Wide-field fundus image from infant ROP screening
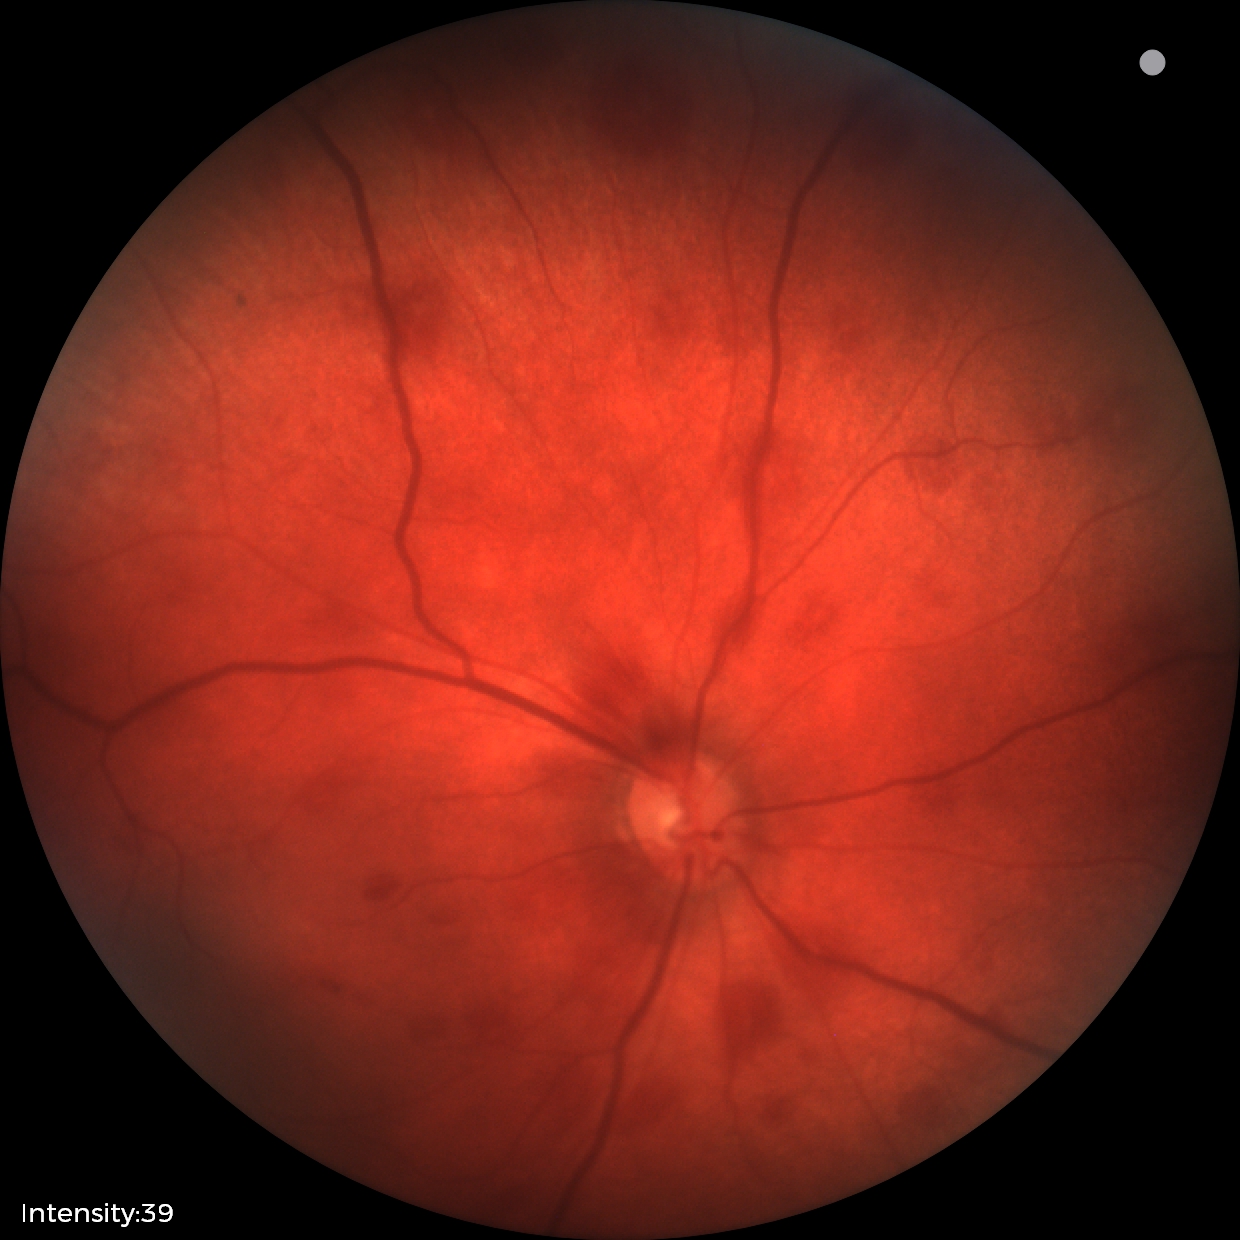
Examination diagnosed as retinal hemorrhages.